Fundus photo; captured on a Remidio Fundus on Phone (FOP) camera: 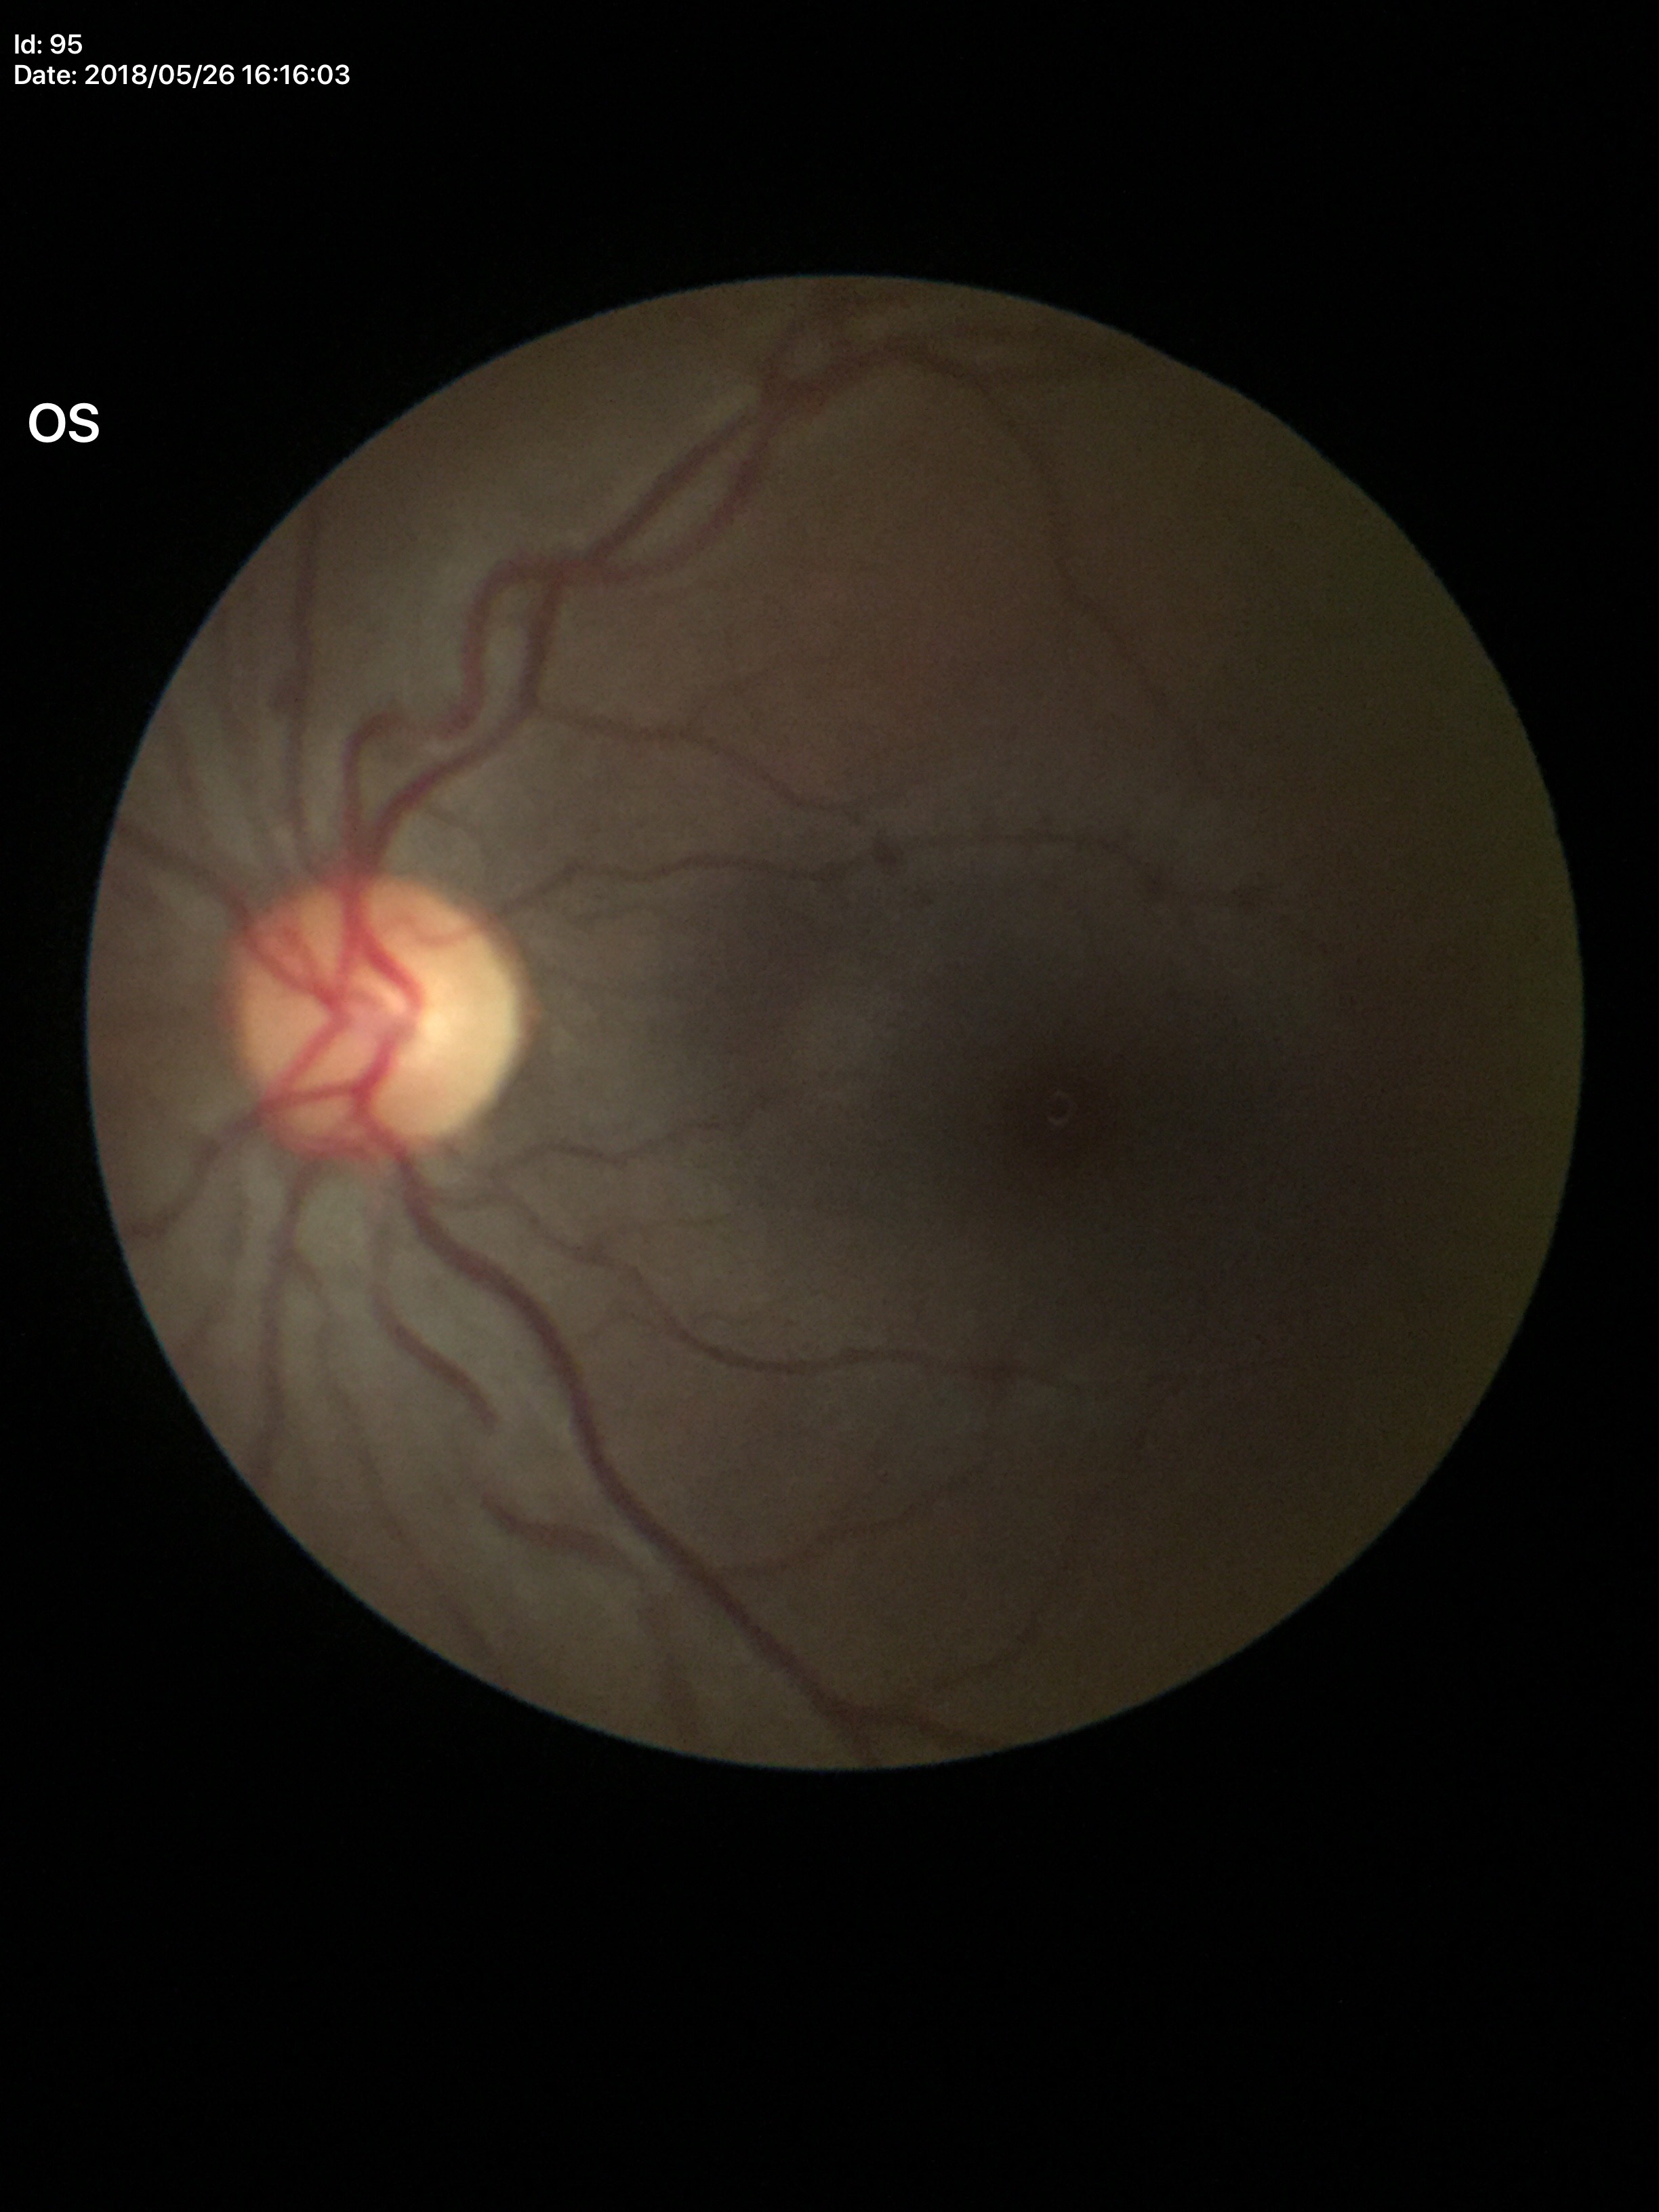
No glaucomatous findings (all 5 graders called normal).
Vertical C/D ratio (VCDR) is 0.49.
Horizontal CDR (HCDR): 0.52.